2352 by 1568 pixels:
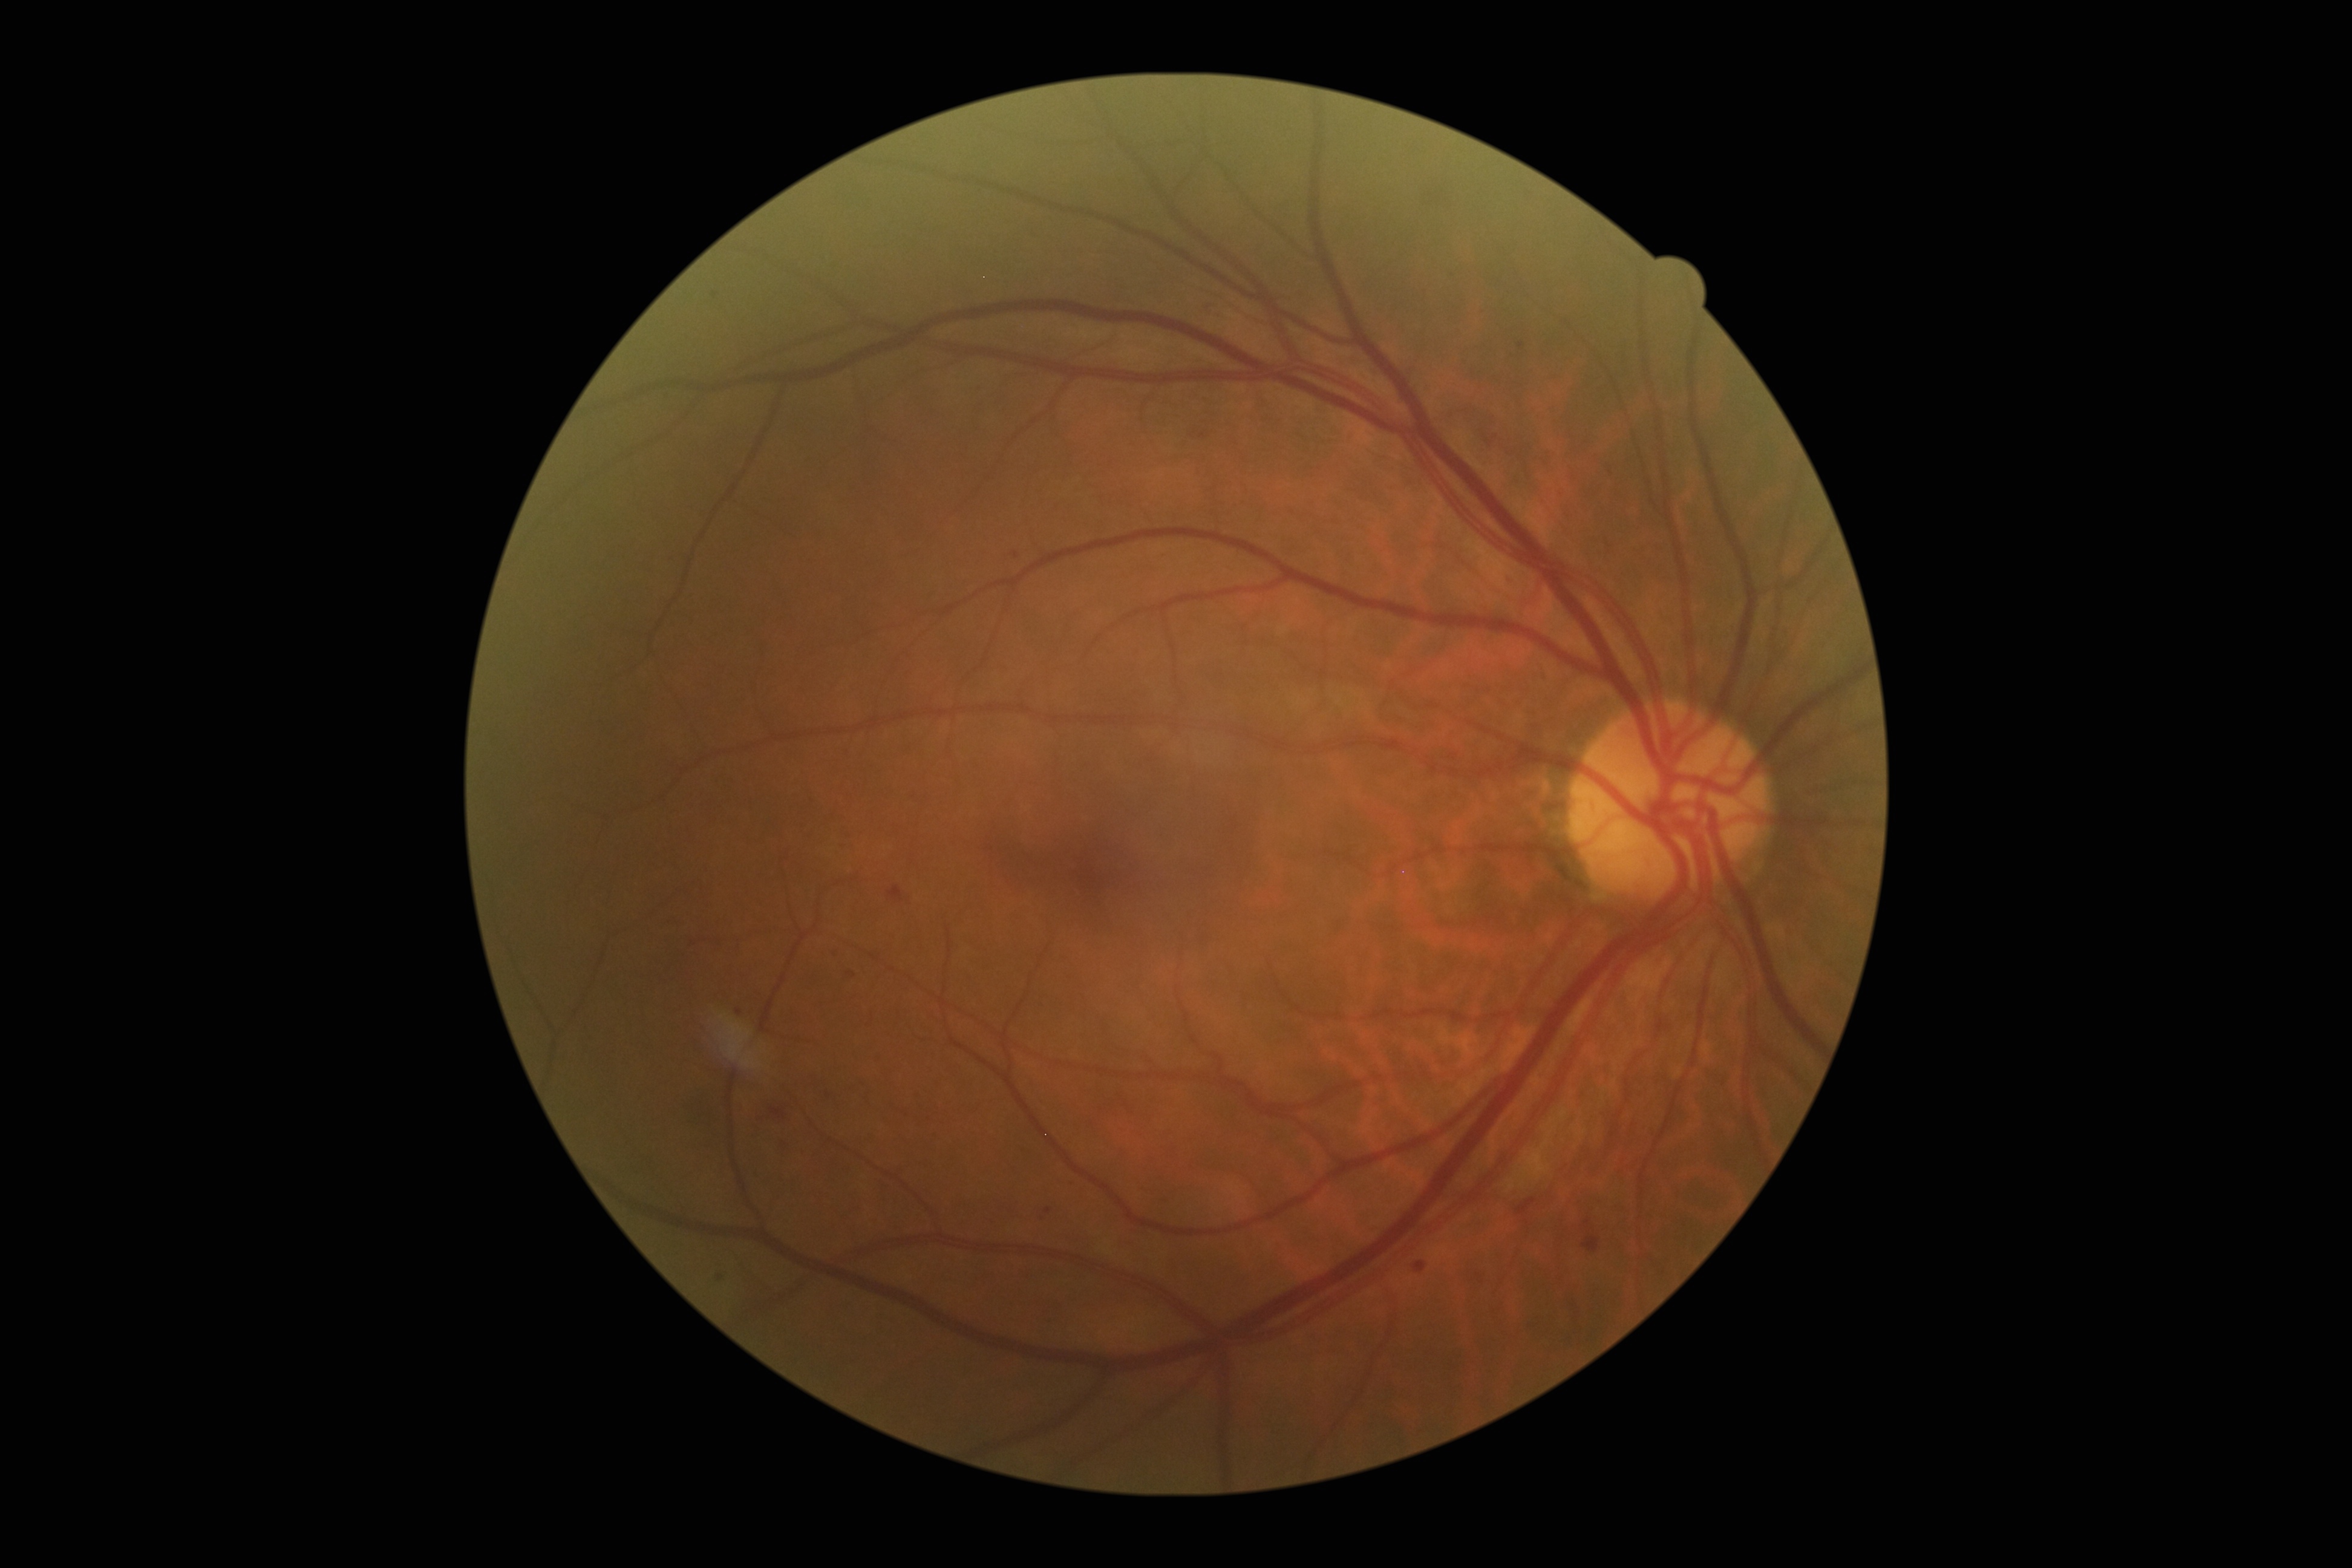

diabetic retinopathy (DR)@moderate non-proliferative diabetic retinopathy (grade 2).